Color fundus photograph:
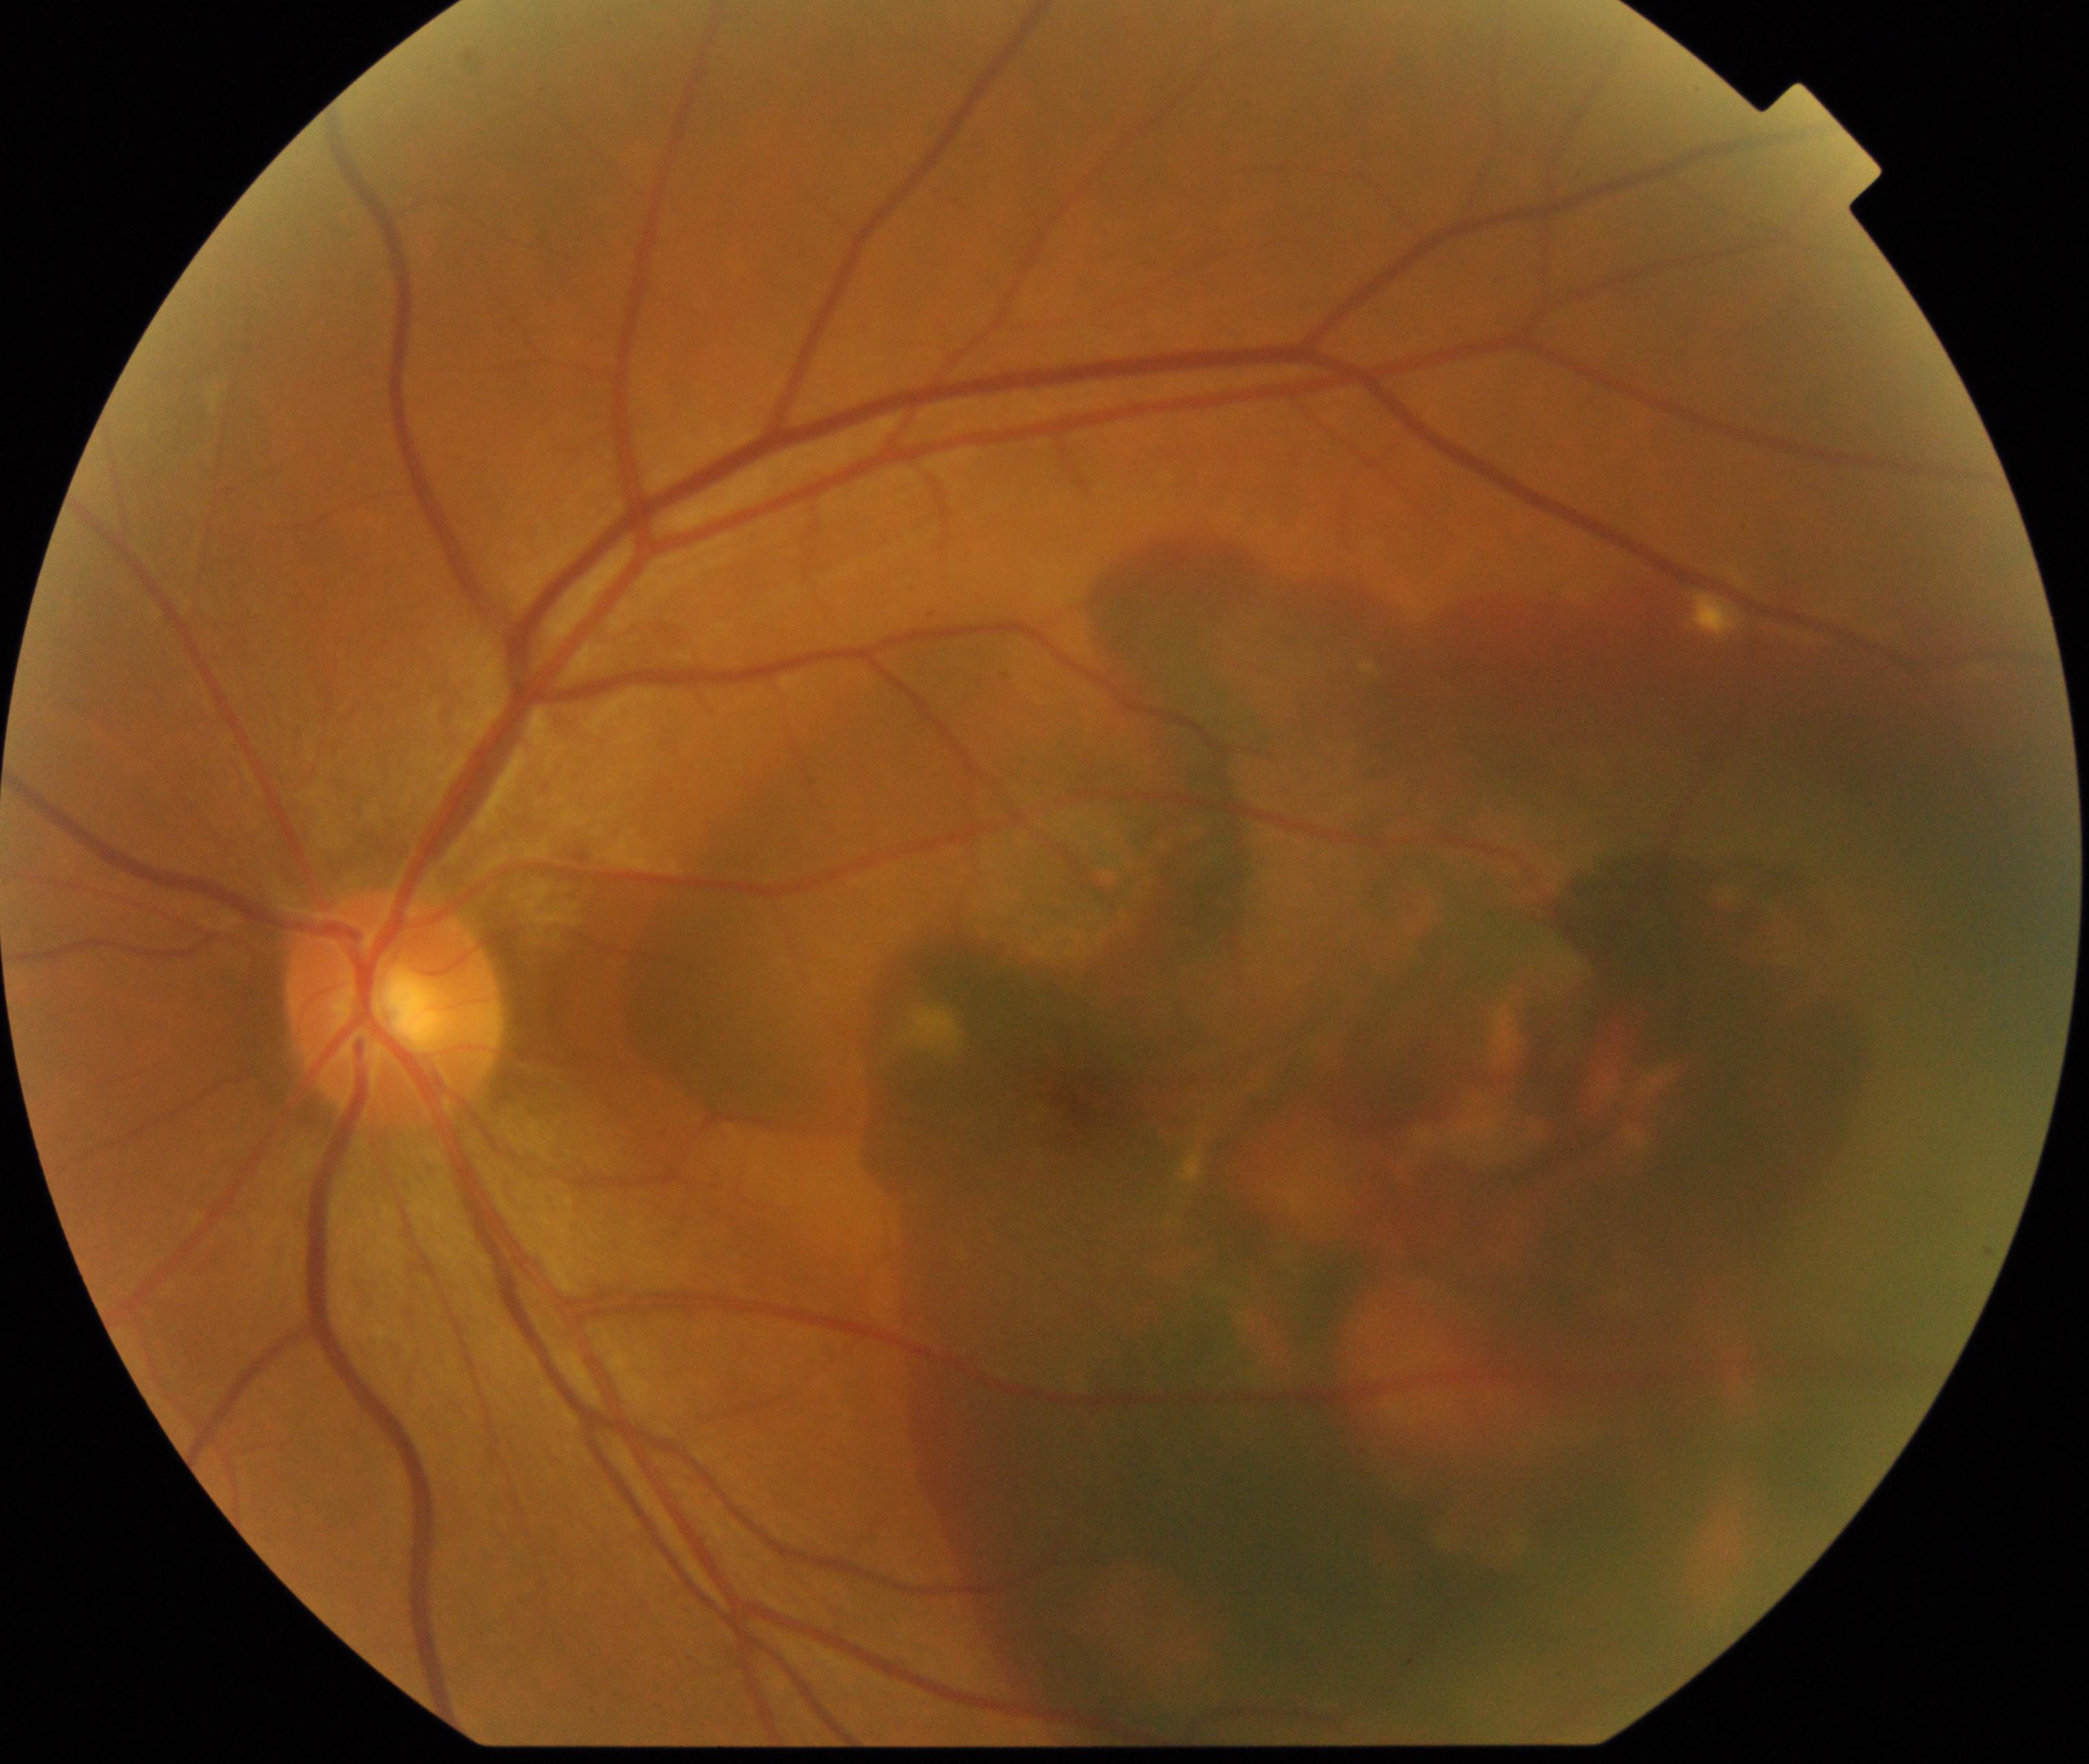
Findings: maculopathy. Typically showing lesions within the macular area, such as intermediate or neovascular age-related macular degeneration, retinal angiomatous proliferation, polypoidal choroidal vasculopathy, choroidal neovascularization, idiopathic macular telangiectasia, and macular atrophy, not caused by other listed disease categories.